240x240 — 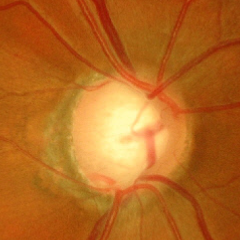

Glaucomatous changes are present.
Severe glaucomatous damage.